Wide-field fundus photograph from neonatal ROP screening. Captured with the Clarity RetCam 3 (130° field of view): 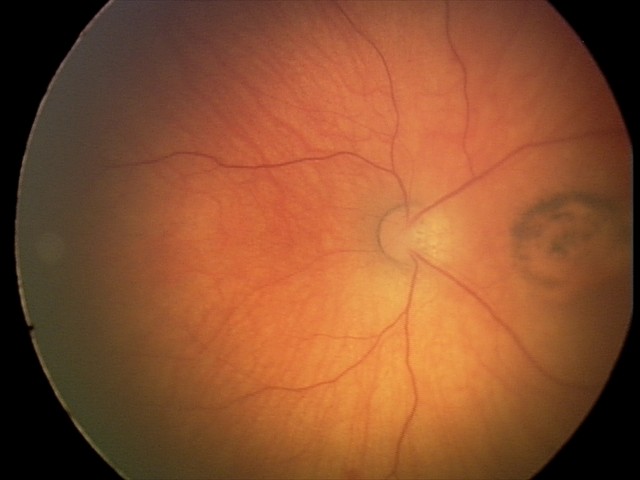
Diagnosis from this screening exam: toxoplasmosis chorioretinitis.